Color fundus image — 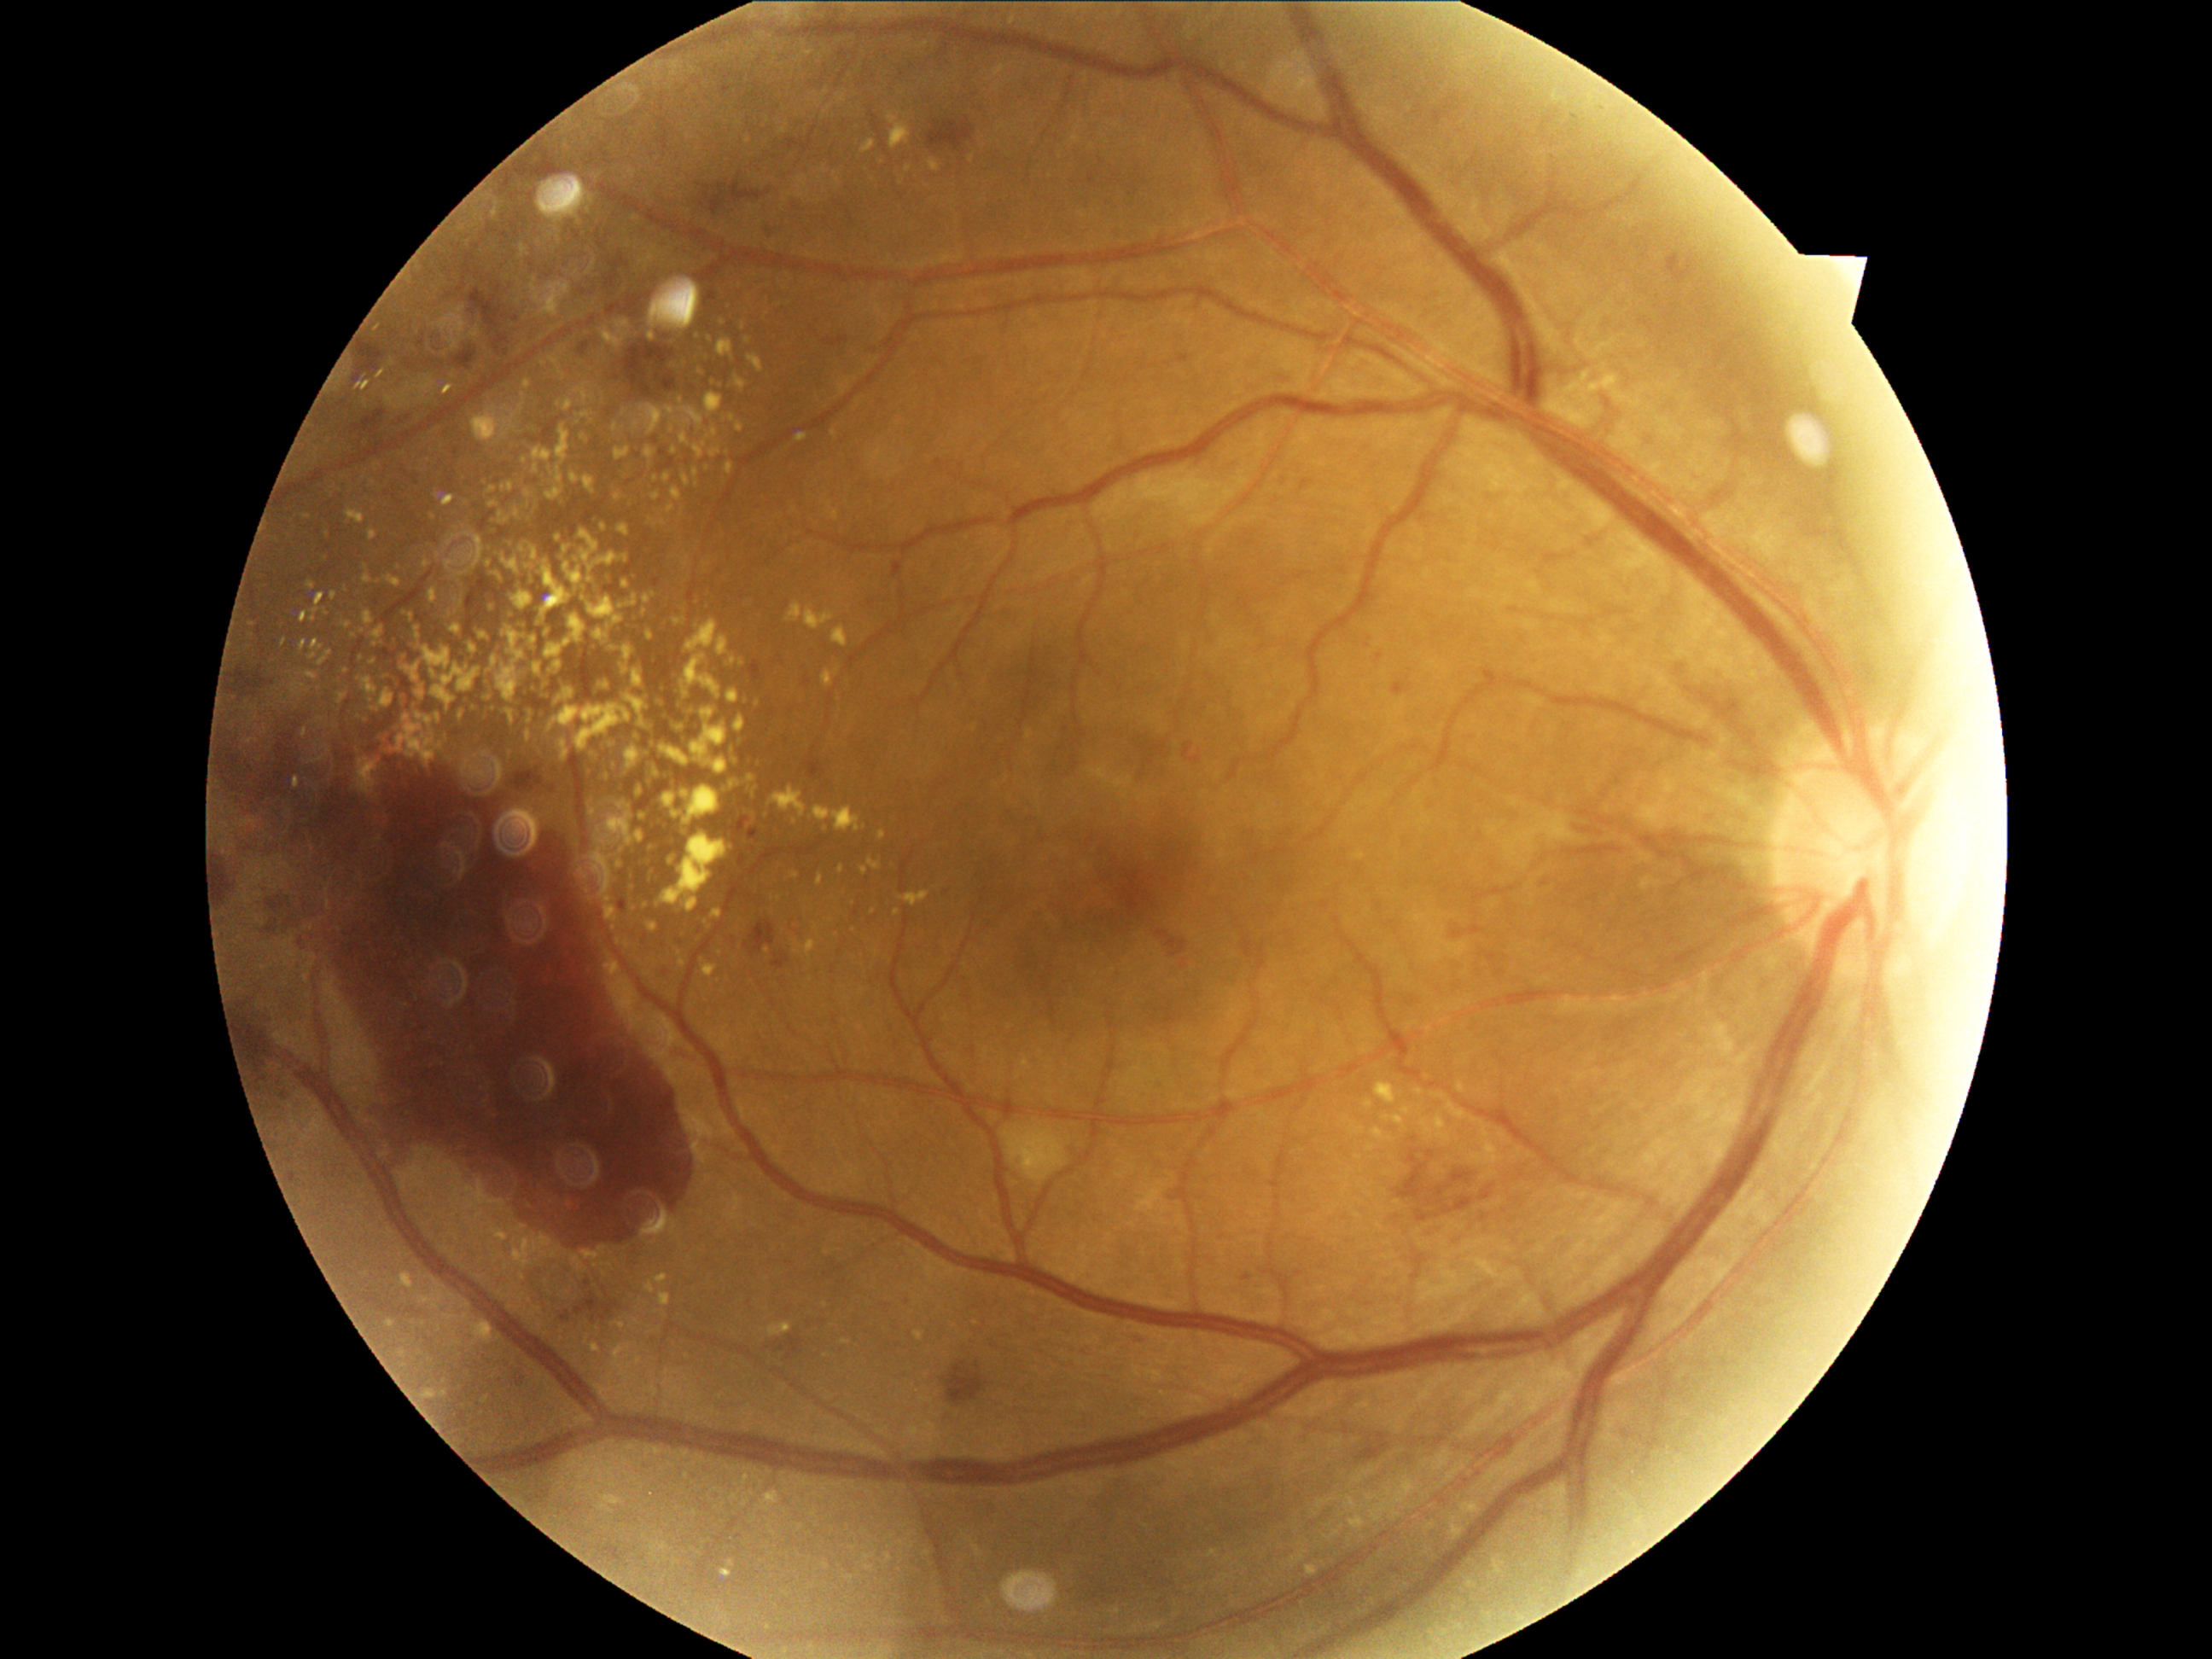 Diabetic retinopathy: proliferative diabetic retinopathy (grade 4) — neovascularization and/or vitreous/pre-retinal hemorrhage; proliferative diabetic retinopathy
Representative lesions:
soft exudates: none
hard exudates (partial): left=470, top=644, right=477, bottom=655; left=711, top=429, right=718, bottom=438; left=709, top=450, right=721, bottom=457; left=416, top=713, right=433, bottom=726; left=450, top=626, right=463, bottom=636; left=434, top=714, right=441, bottom=723; left=489, top=503, right=498, bottom=508; left=656, top=830, right=736, bottom=914; left=660, top=745, right=690, bottom=767; left=747, top=776, right=757, bottom=793; left=404, top=663, right=421, bottom=684; left=306, top=672, right=318, bottom=680
Small hard exudates approximately at Point(653, 827); Point(528, 384); Point(392, 647); Point(1470, 1584); Point(501, 515); Point(522, 549); Point(1478, 1158); Point(1013, 20)
microaneurysms (partial): left=620, top=900, right=627, bottom=912; left=1131, top=1334, right=1143, bottom=1346; left=1278, top=373, right=1283, bottom=388; left=665, top=970, right=675, bottom=986; left=769, top=228, right=783, bottom=236; left=1677, top=253, right=1691, bottom=265; left=1184, top=743, right=1194, bottom=759; left=1394, top=682, right=1406, bottom=697; left=1377, top=655, right=1385, bottom=661; left=583, top=1276, right=590, bottom=1289; left=733, top=817, right=750, bottom=837; left=750, top=661, right=760, bottom=680; left=579, top=342, right=590, bottom=354; left=516, top=1375, right=523, bottom=1385
Small microaneurysms approximately at Point(726, 91); Point(1247, 1278); Point(657, 582)
hemorrhages (partial): left=948, top=1365, right=986, bottom=1402; left=704, top=183, right=764, bottom=218; left=774, top=957, right=789, bottom=970; left=1428, top=1168, right=1474, bottom=1218; left=1416, top=1211, right=1429, bottom=1223; left=562, top=1315, right=571, bottom=1322; left=1455, top=923, right=1486, bottom=938; left=223, top=716, right=697, bottom=1257; left=605, top=260, right=626, bottom=289; left=576, top=1295, right=612, bottom=1322; left=926, top=119, right=975, bottom=154; left=354, top=410, right=385, bottom=434; left=513, top=772, right=544, bottom=789; left=655, top=375, right=678, bottom=392; left=1576, top=829, right=1604, bottom=842; left=231, top=670, right=260, bottom=697
Small hemorrhages approximately at Point(747, 946); Point(701, 204); Point(516, 320)